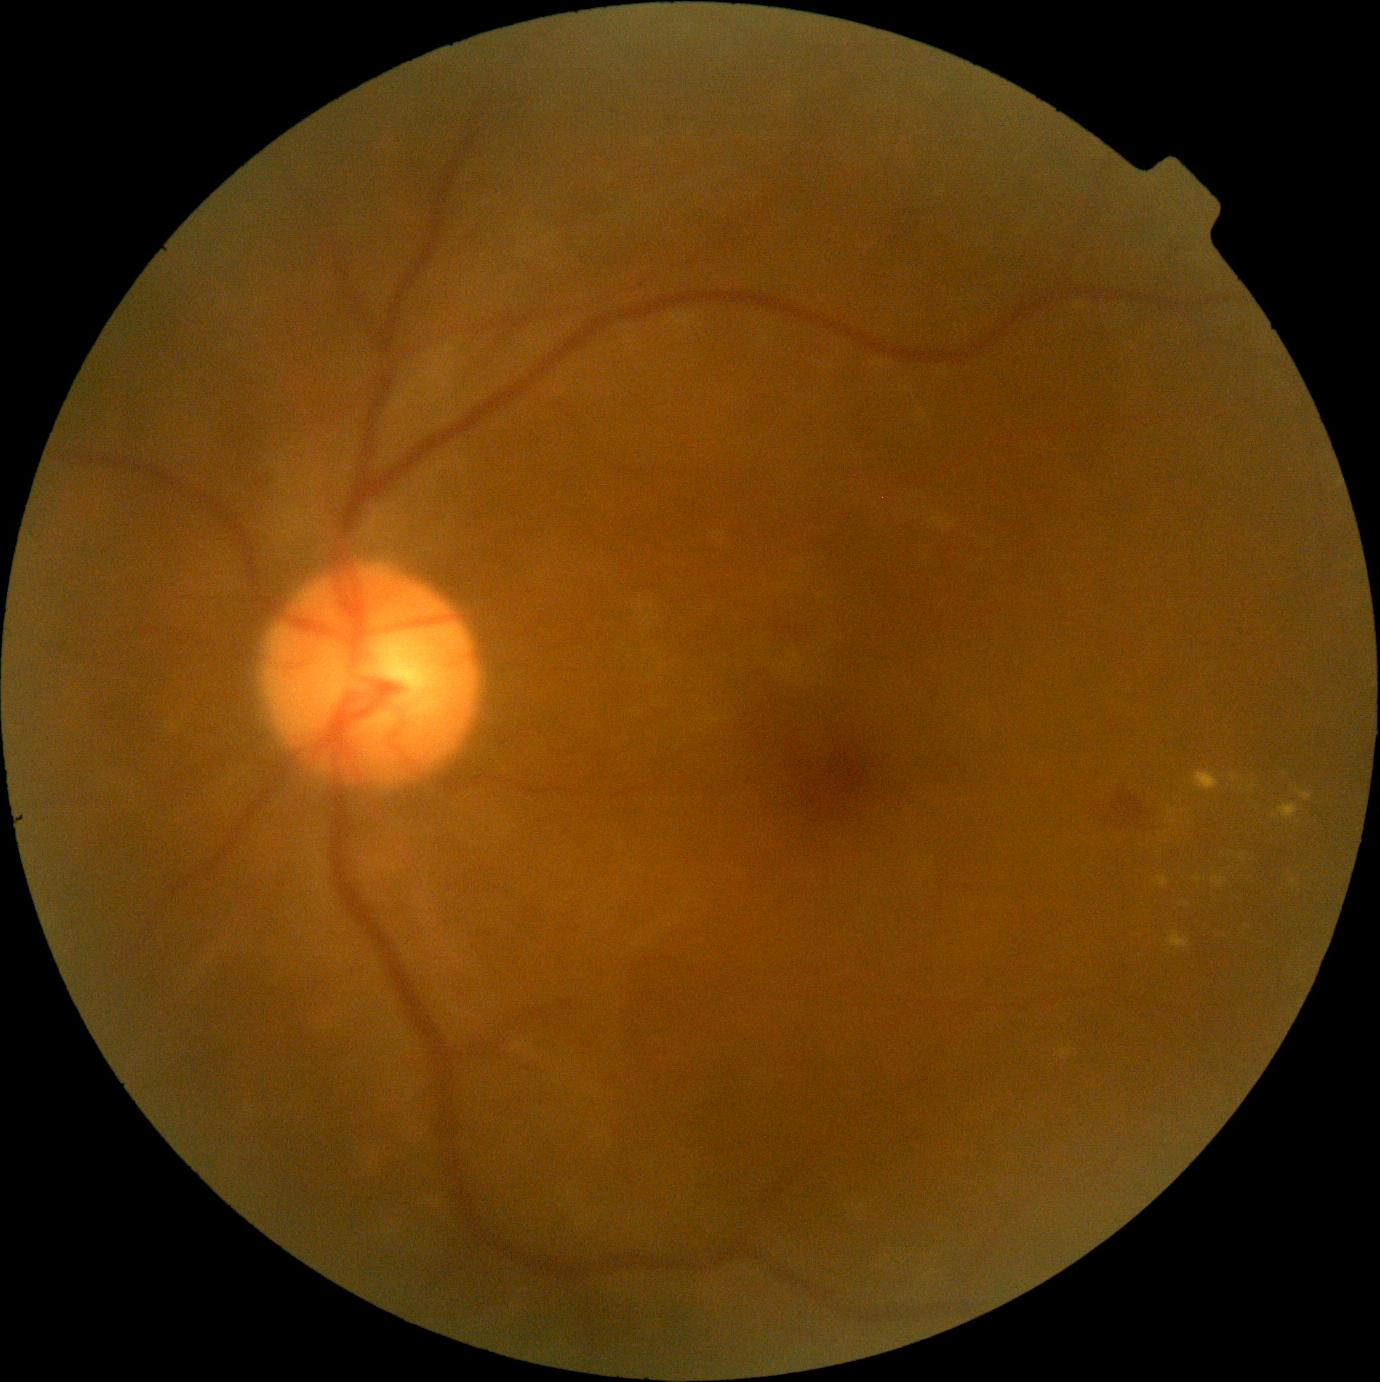
Diabetic retinopathy grade: moderate non-proliferative diabetic retinopathy (2).